Fundus photo — 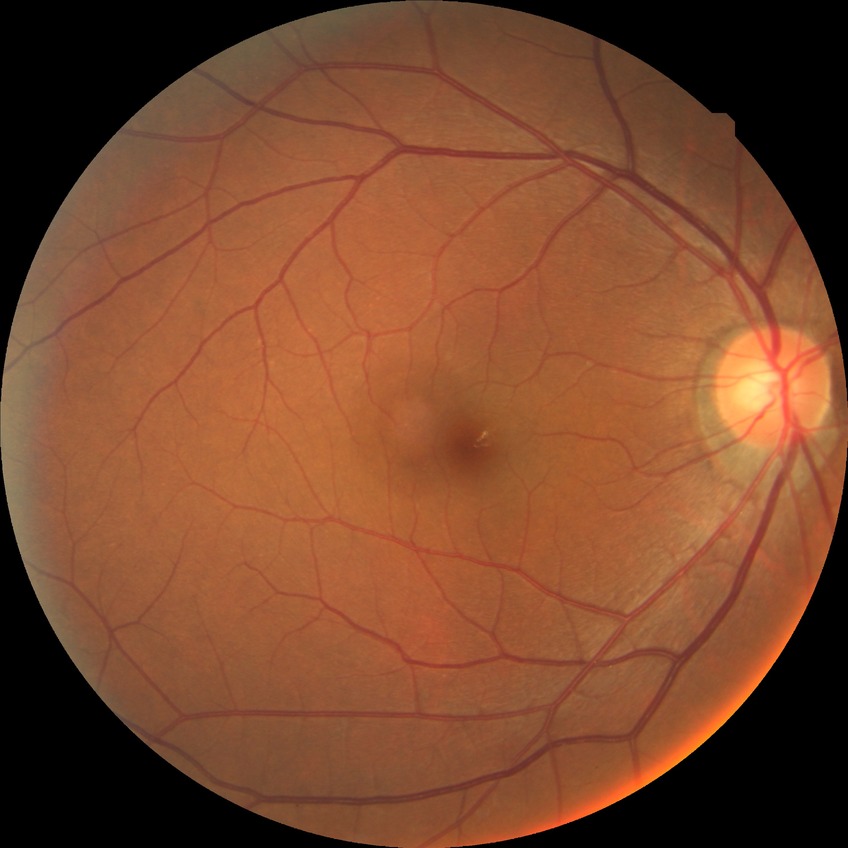

davis_grade: NDR
dr_impression: negative for DR